Graded on the modified Davis scale — 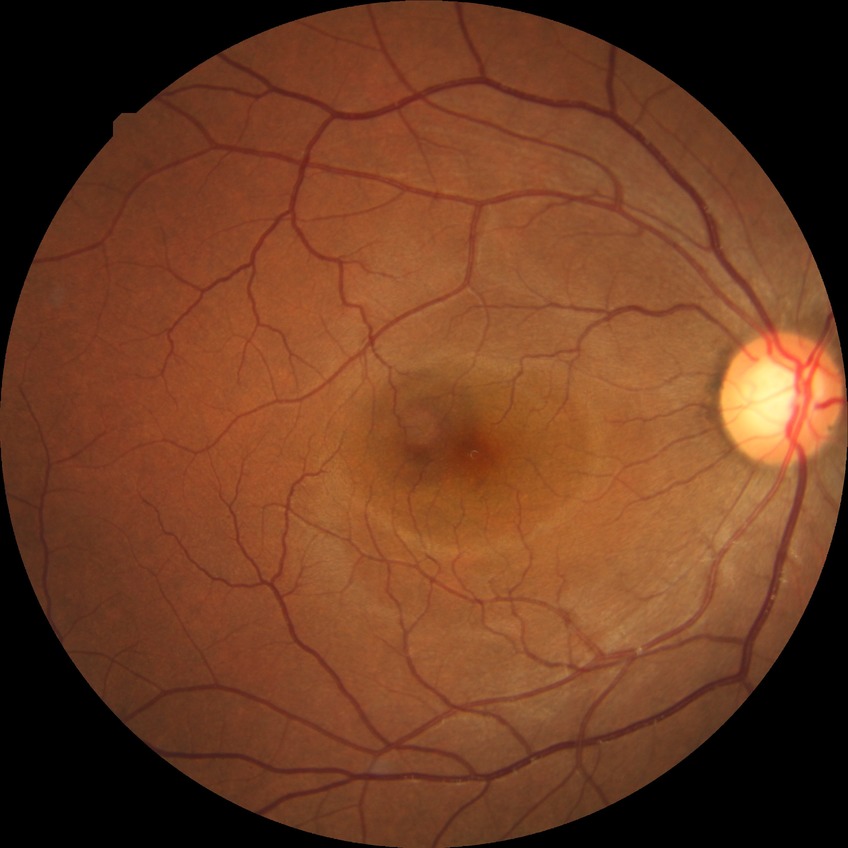
retinopathy stage: no diabetic retinopathy.